Image size 848x848.
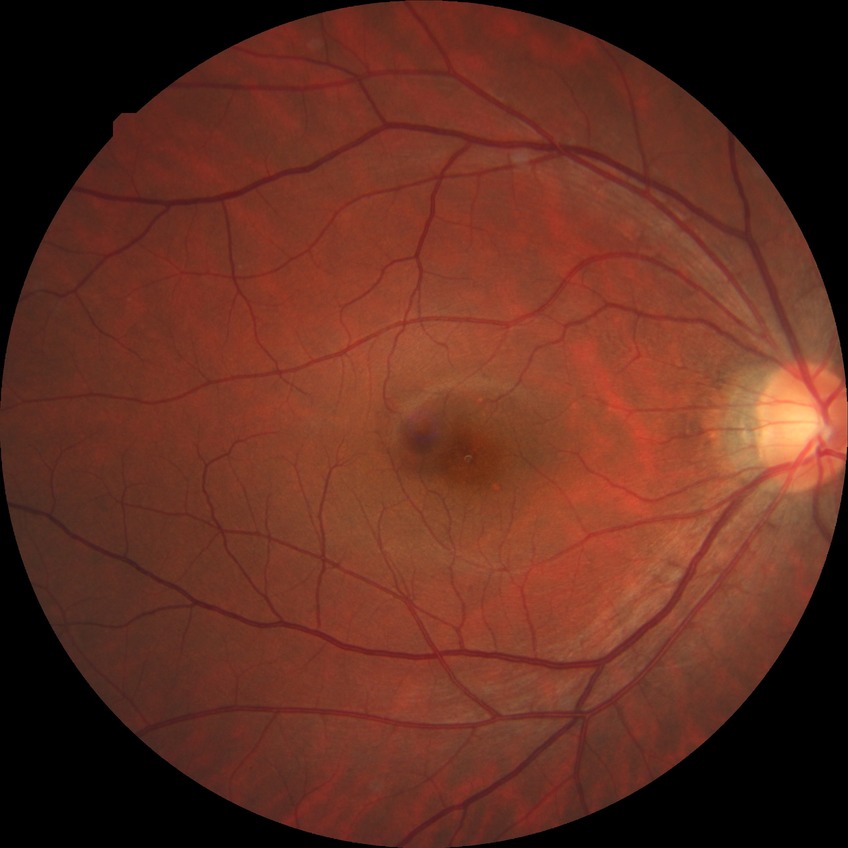 Diabetic retinopathy (DR) is no diabetic retinopathy (NDR).